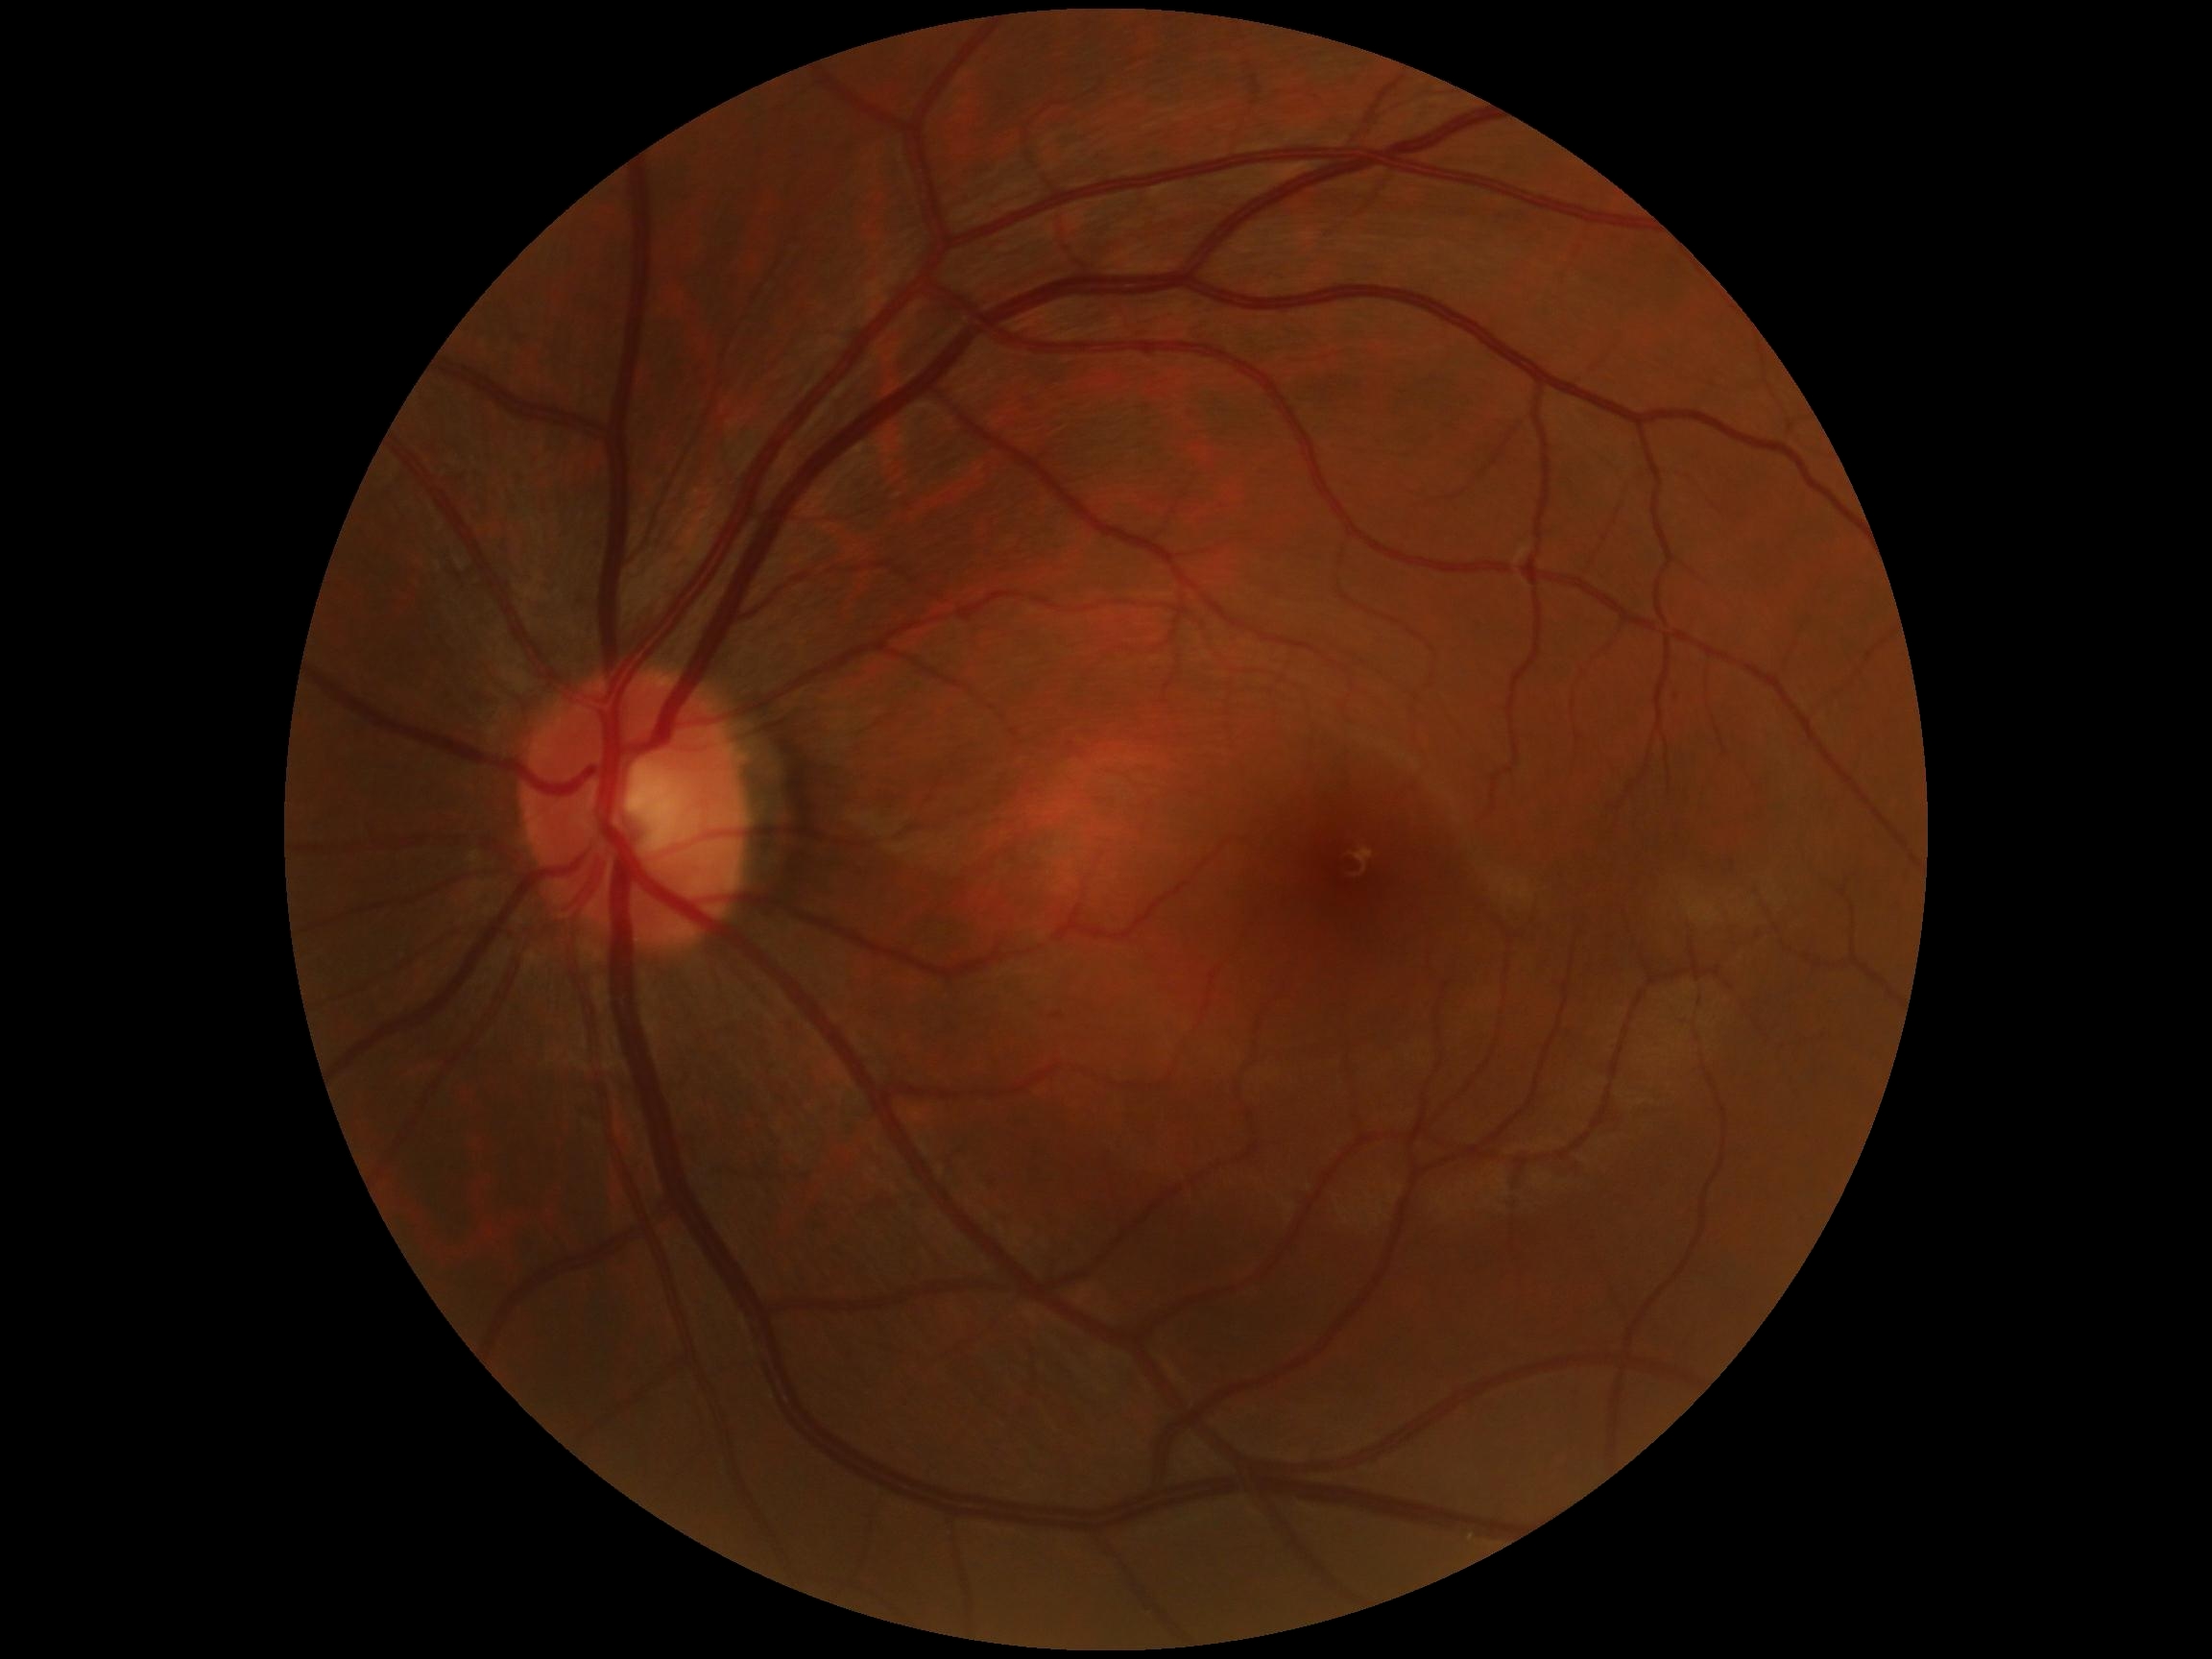 DR stage = grade 0 (no apparent retinopathy) — no visible signs of diabetic retinopathy.